CFP
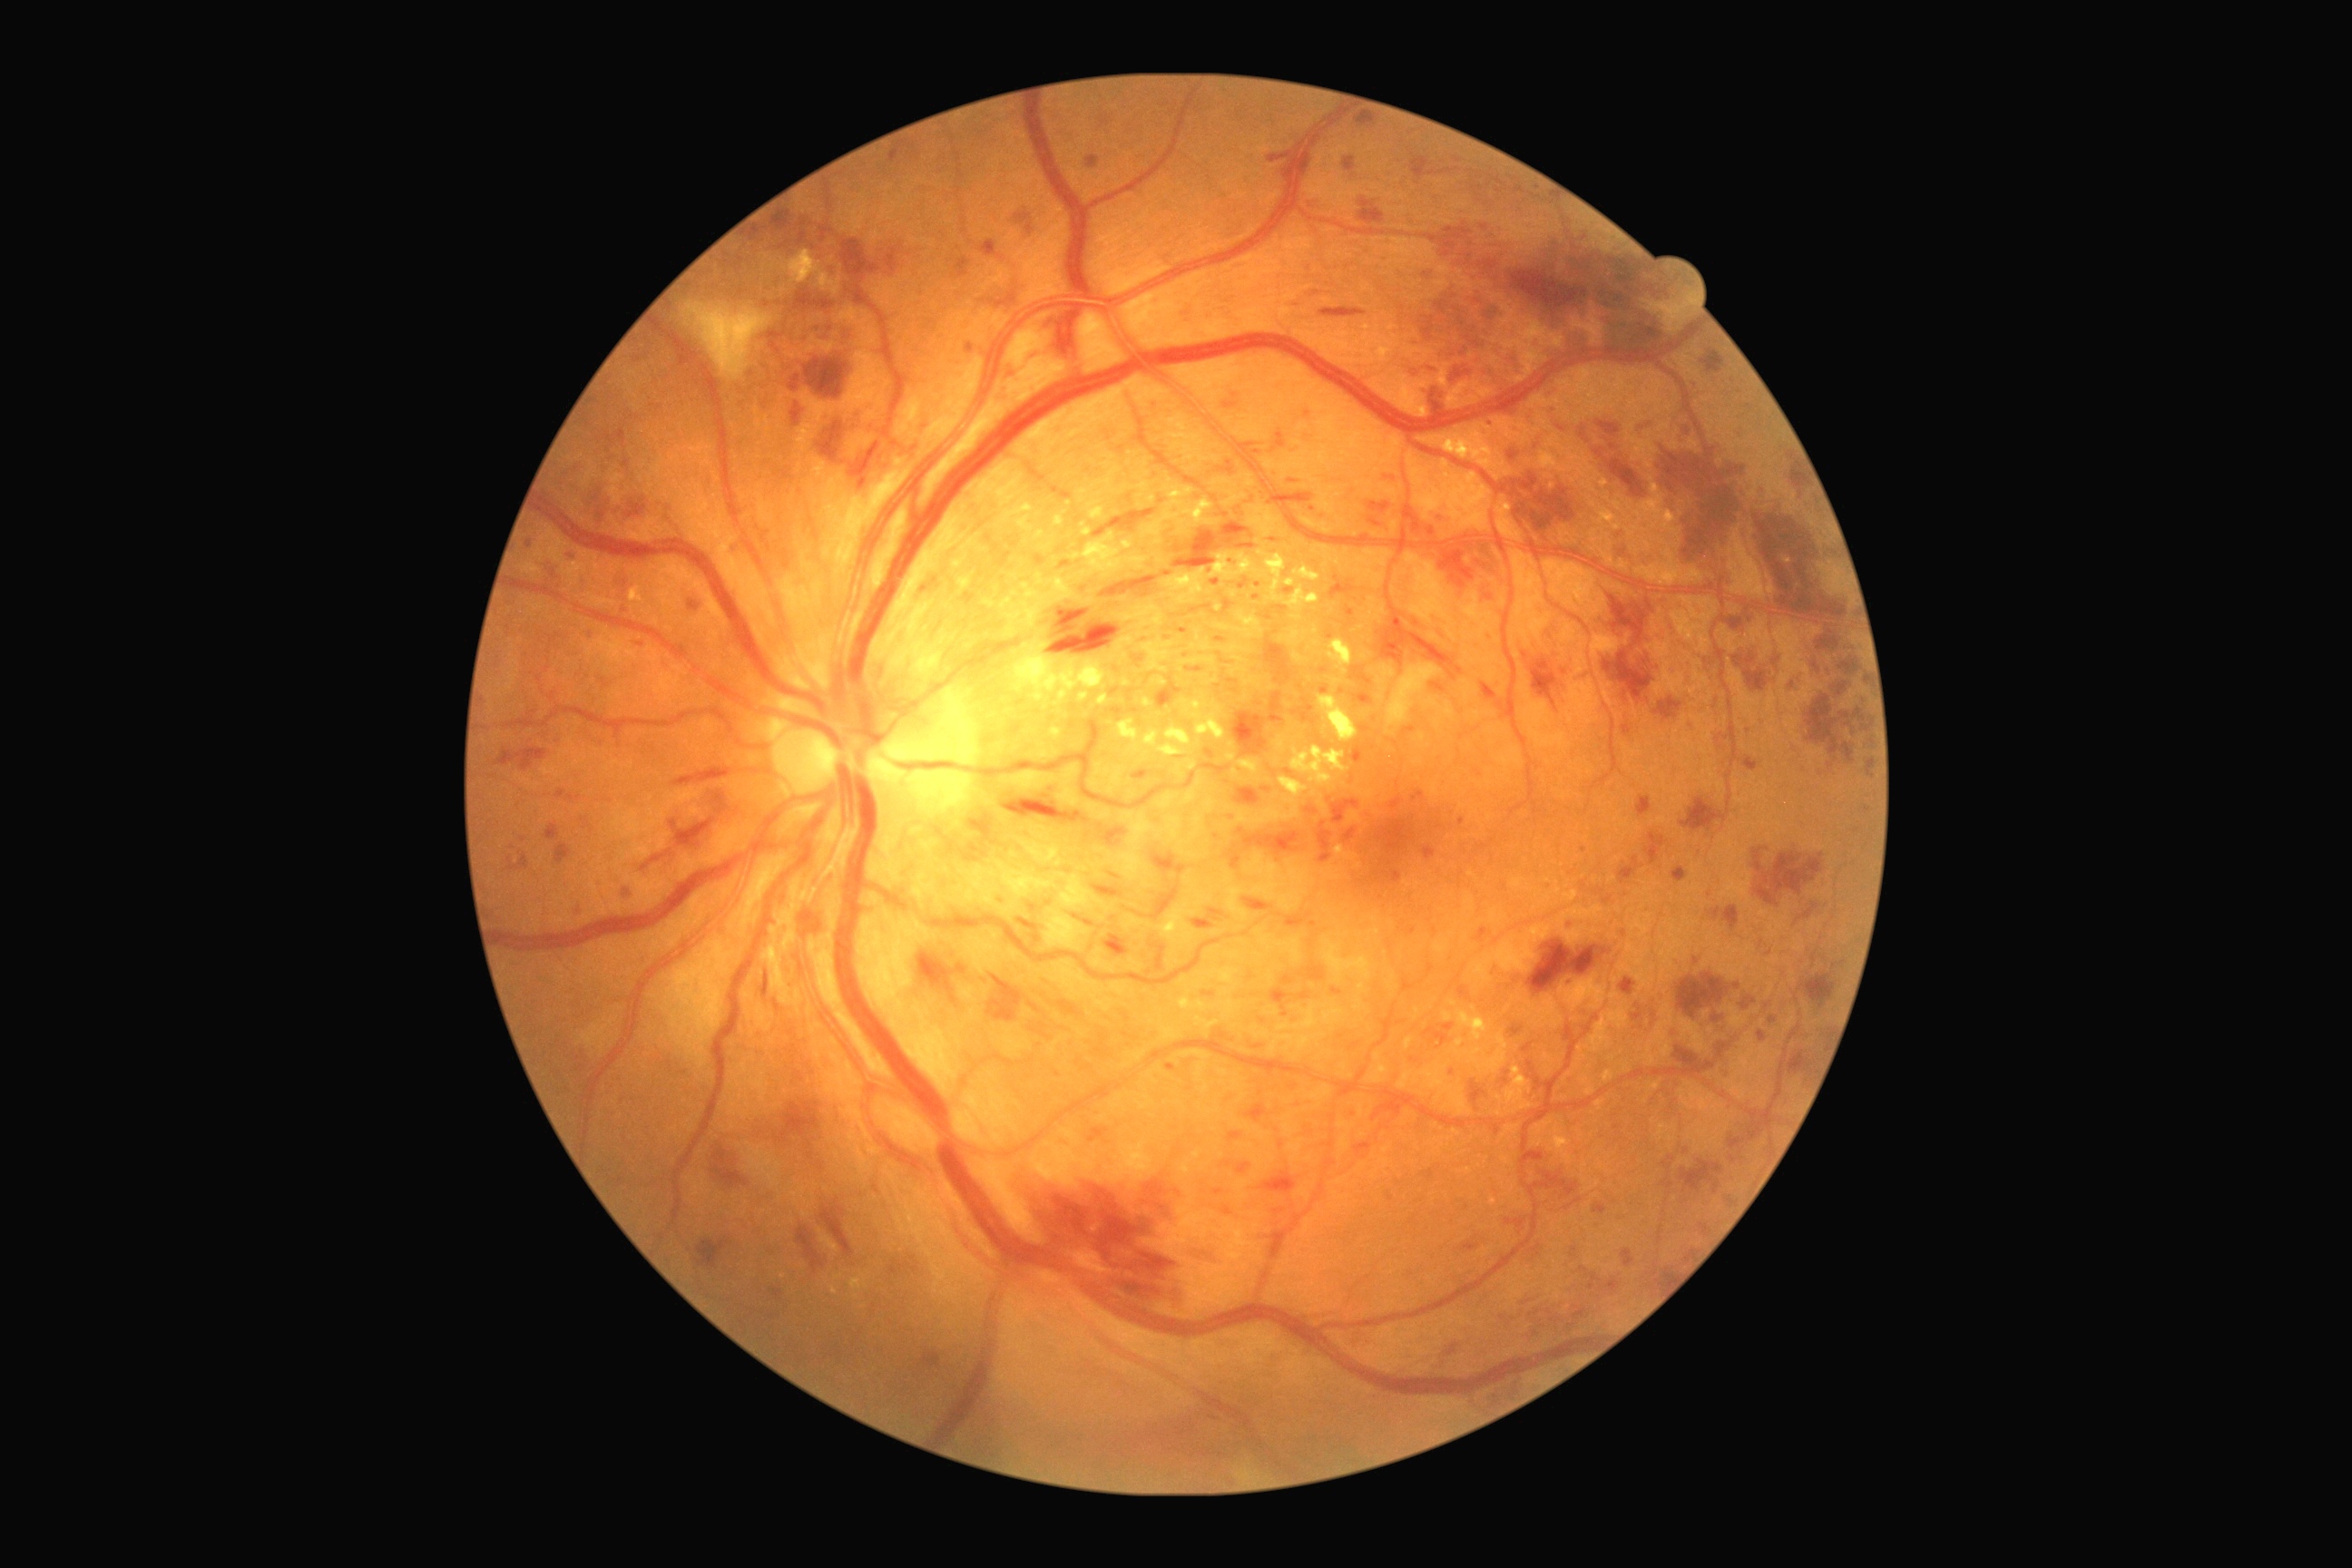
{"partial":true,"dr_grade":3,"dr_grade_name":"severe NPDR","lesions":{"ma":[[1493,966,1500,975],[1431,683,1446,692],[966,346,974,353],[1320,687,1329,692],[770,1288,785,1300],[1059,1001,1081,1017],[1571,1246,1578,1259],[1014,213,1032,226],[1284,591,1293,594],[1026,224,1034,235],[1482,683,1498,700],[1224,402,1239,409],[1237,1164,1251,1175],[1632,1014,1643,1021]],"ma_small_approx":[[1622,1218],[1289,773],[1843,964],[1314,923],[1256,598]]}}